Fundus photo.
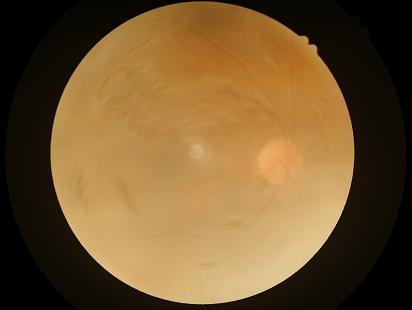 Contrast: low
Clarity: blurry
Illumination/color: suboptimal
Overall: inadequate